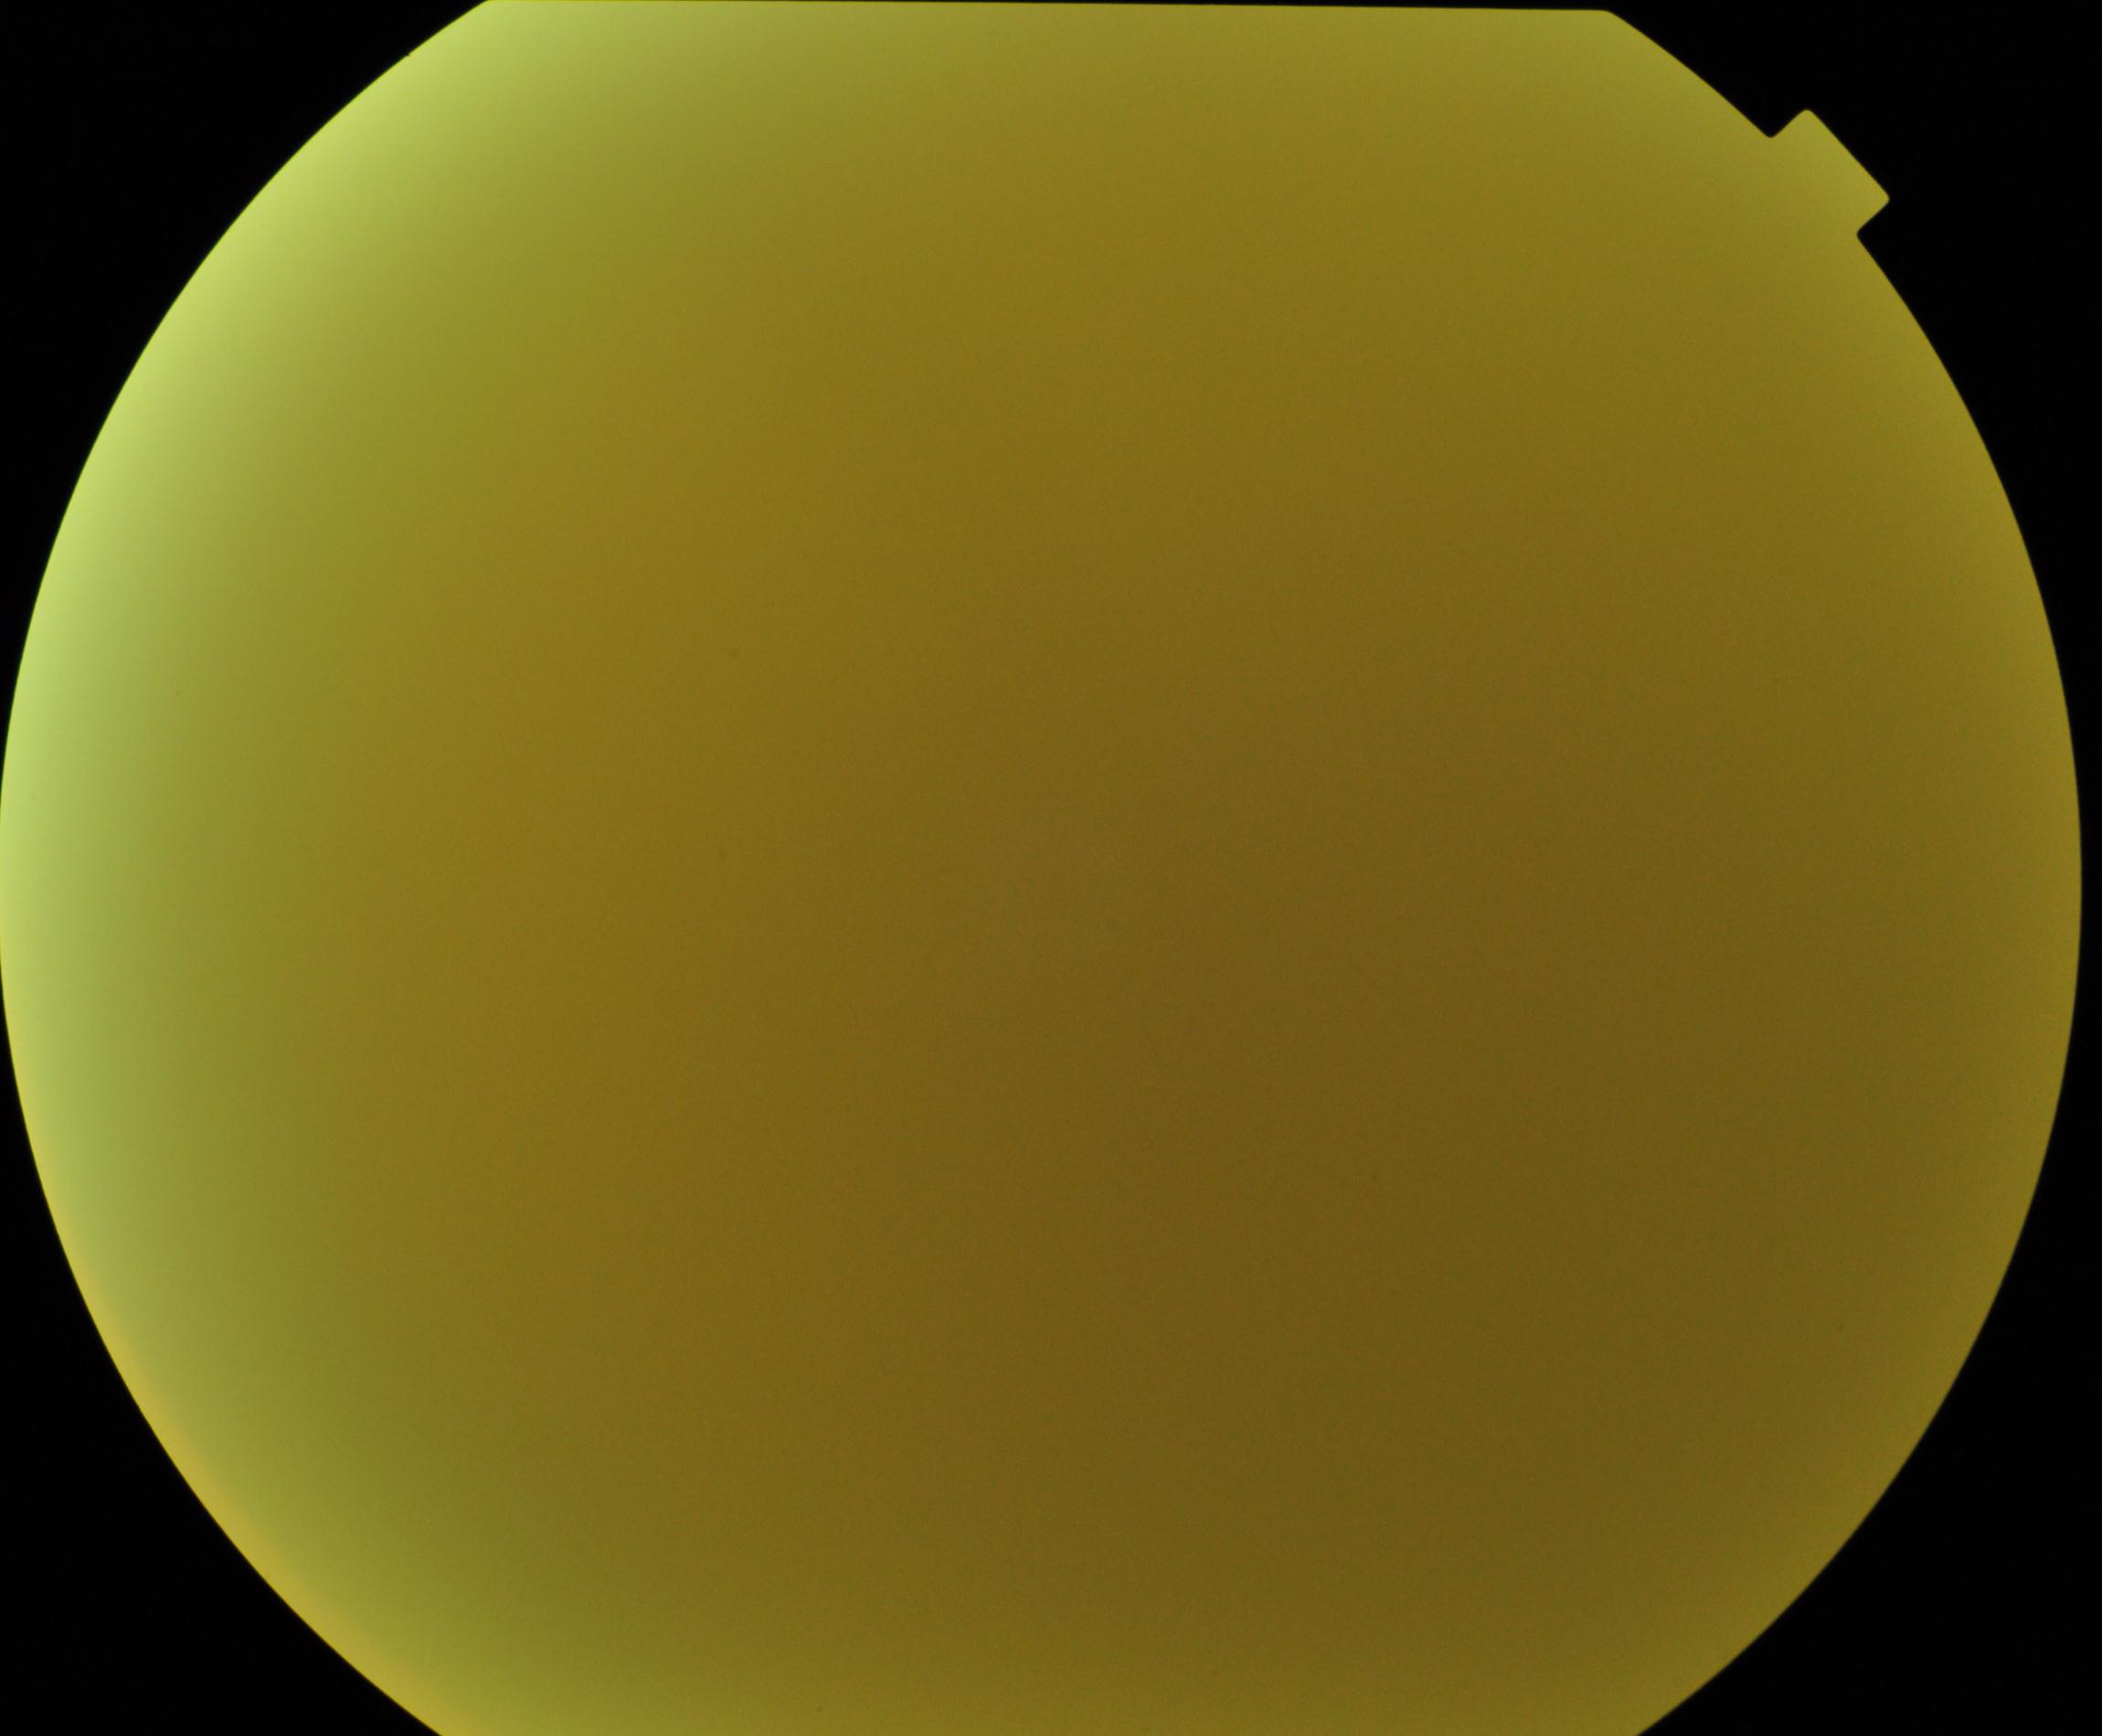

Image quality is poor; more than half the field is obscured. No evidence of proliferative diabetic retinopathy.